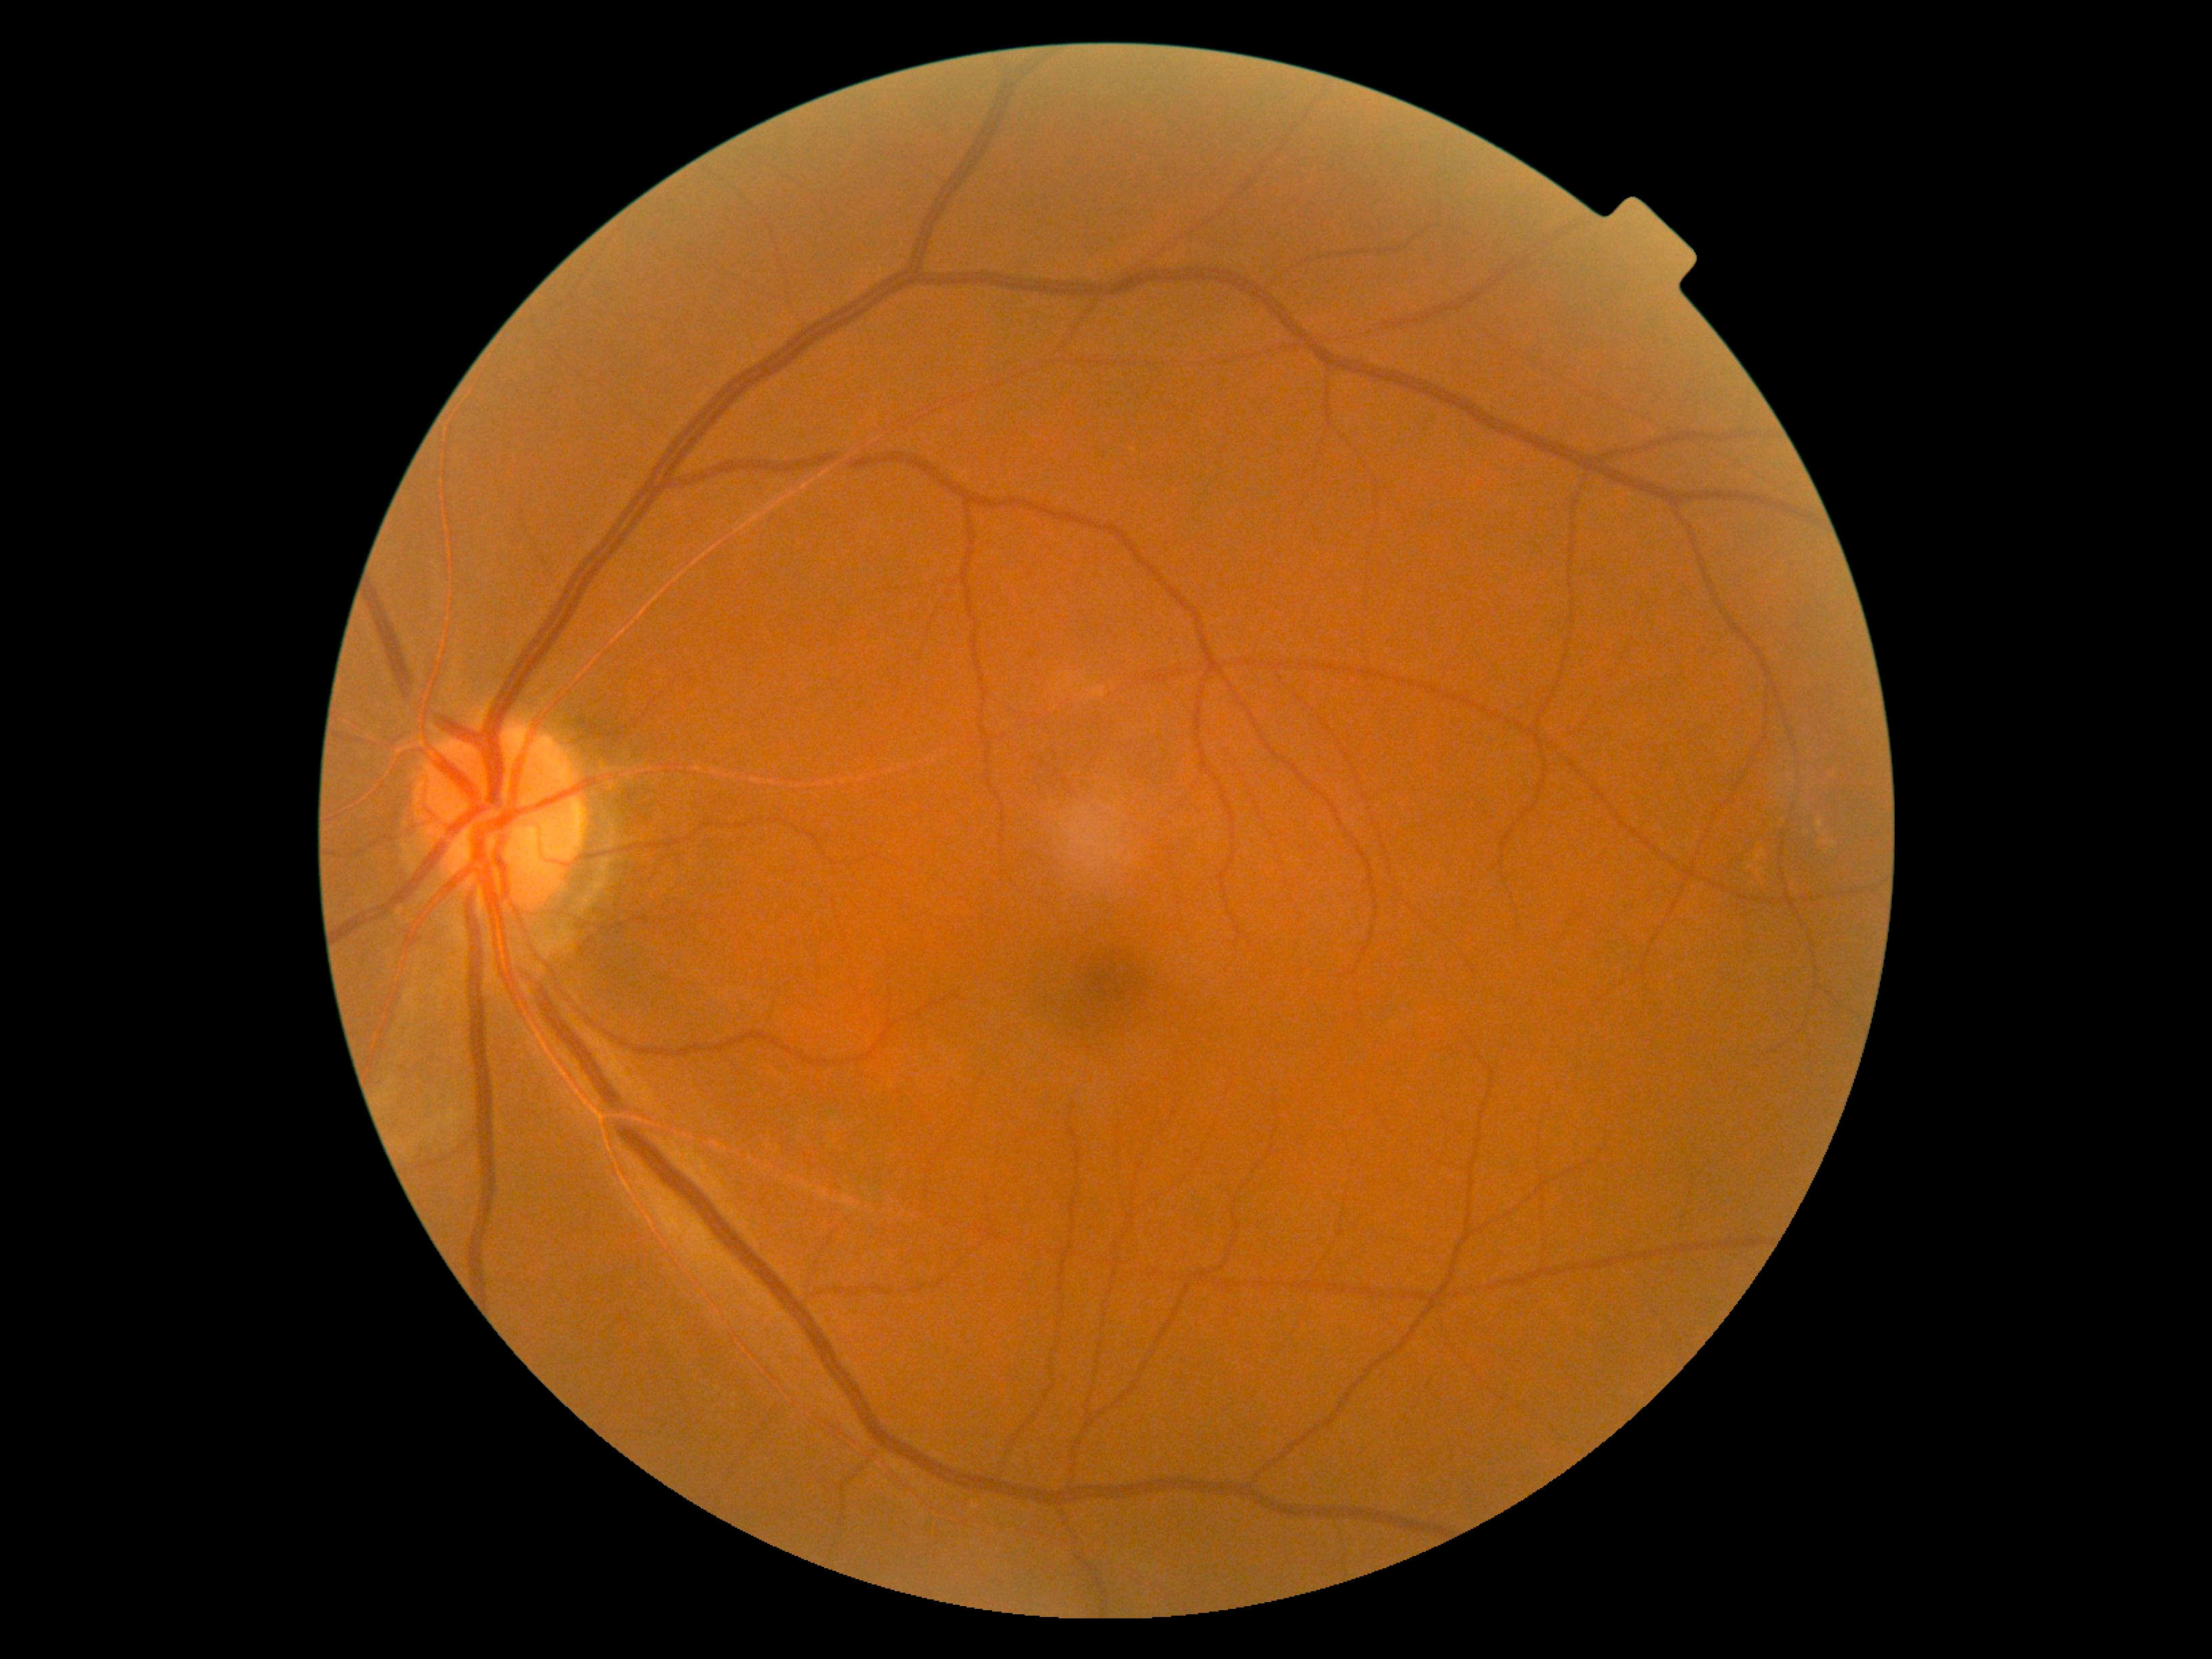

DR severity: grade 0 (no apparent retinopathy).